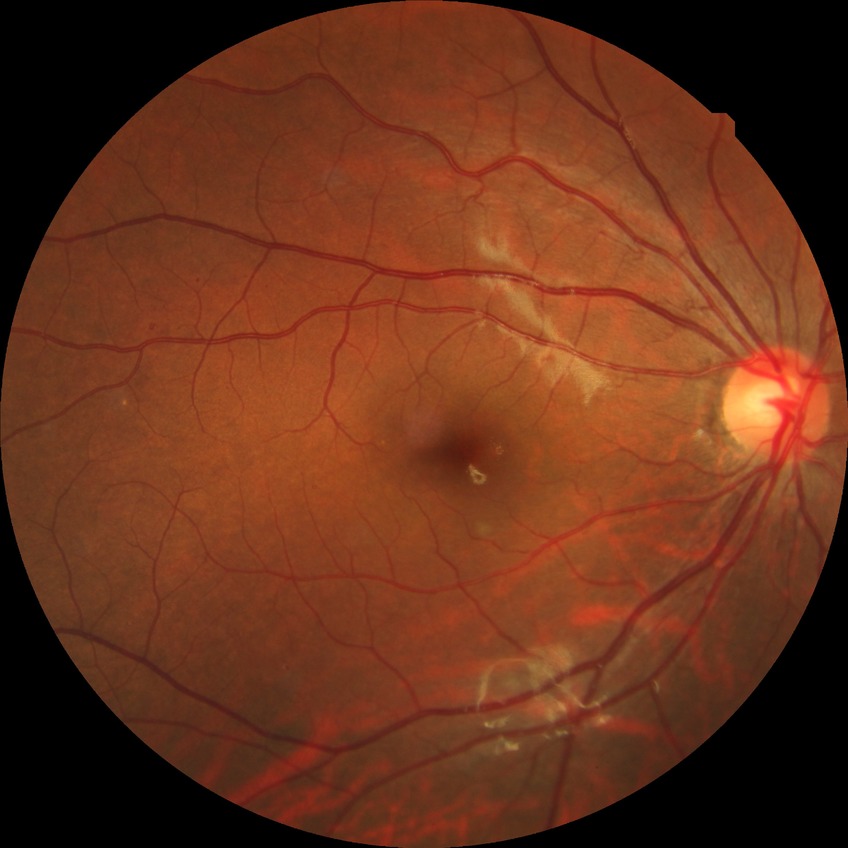 Diabetic retinopathy (DR) is simple diabetic retinopathy (SDR). The retinopathy is classified as non-proliferative diabetic retinopathy.